CFP; FOV: 45 degrees.
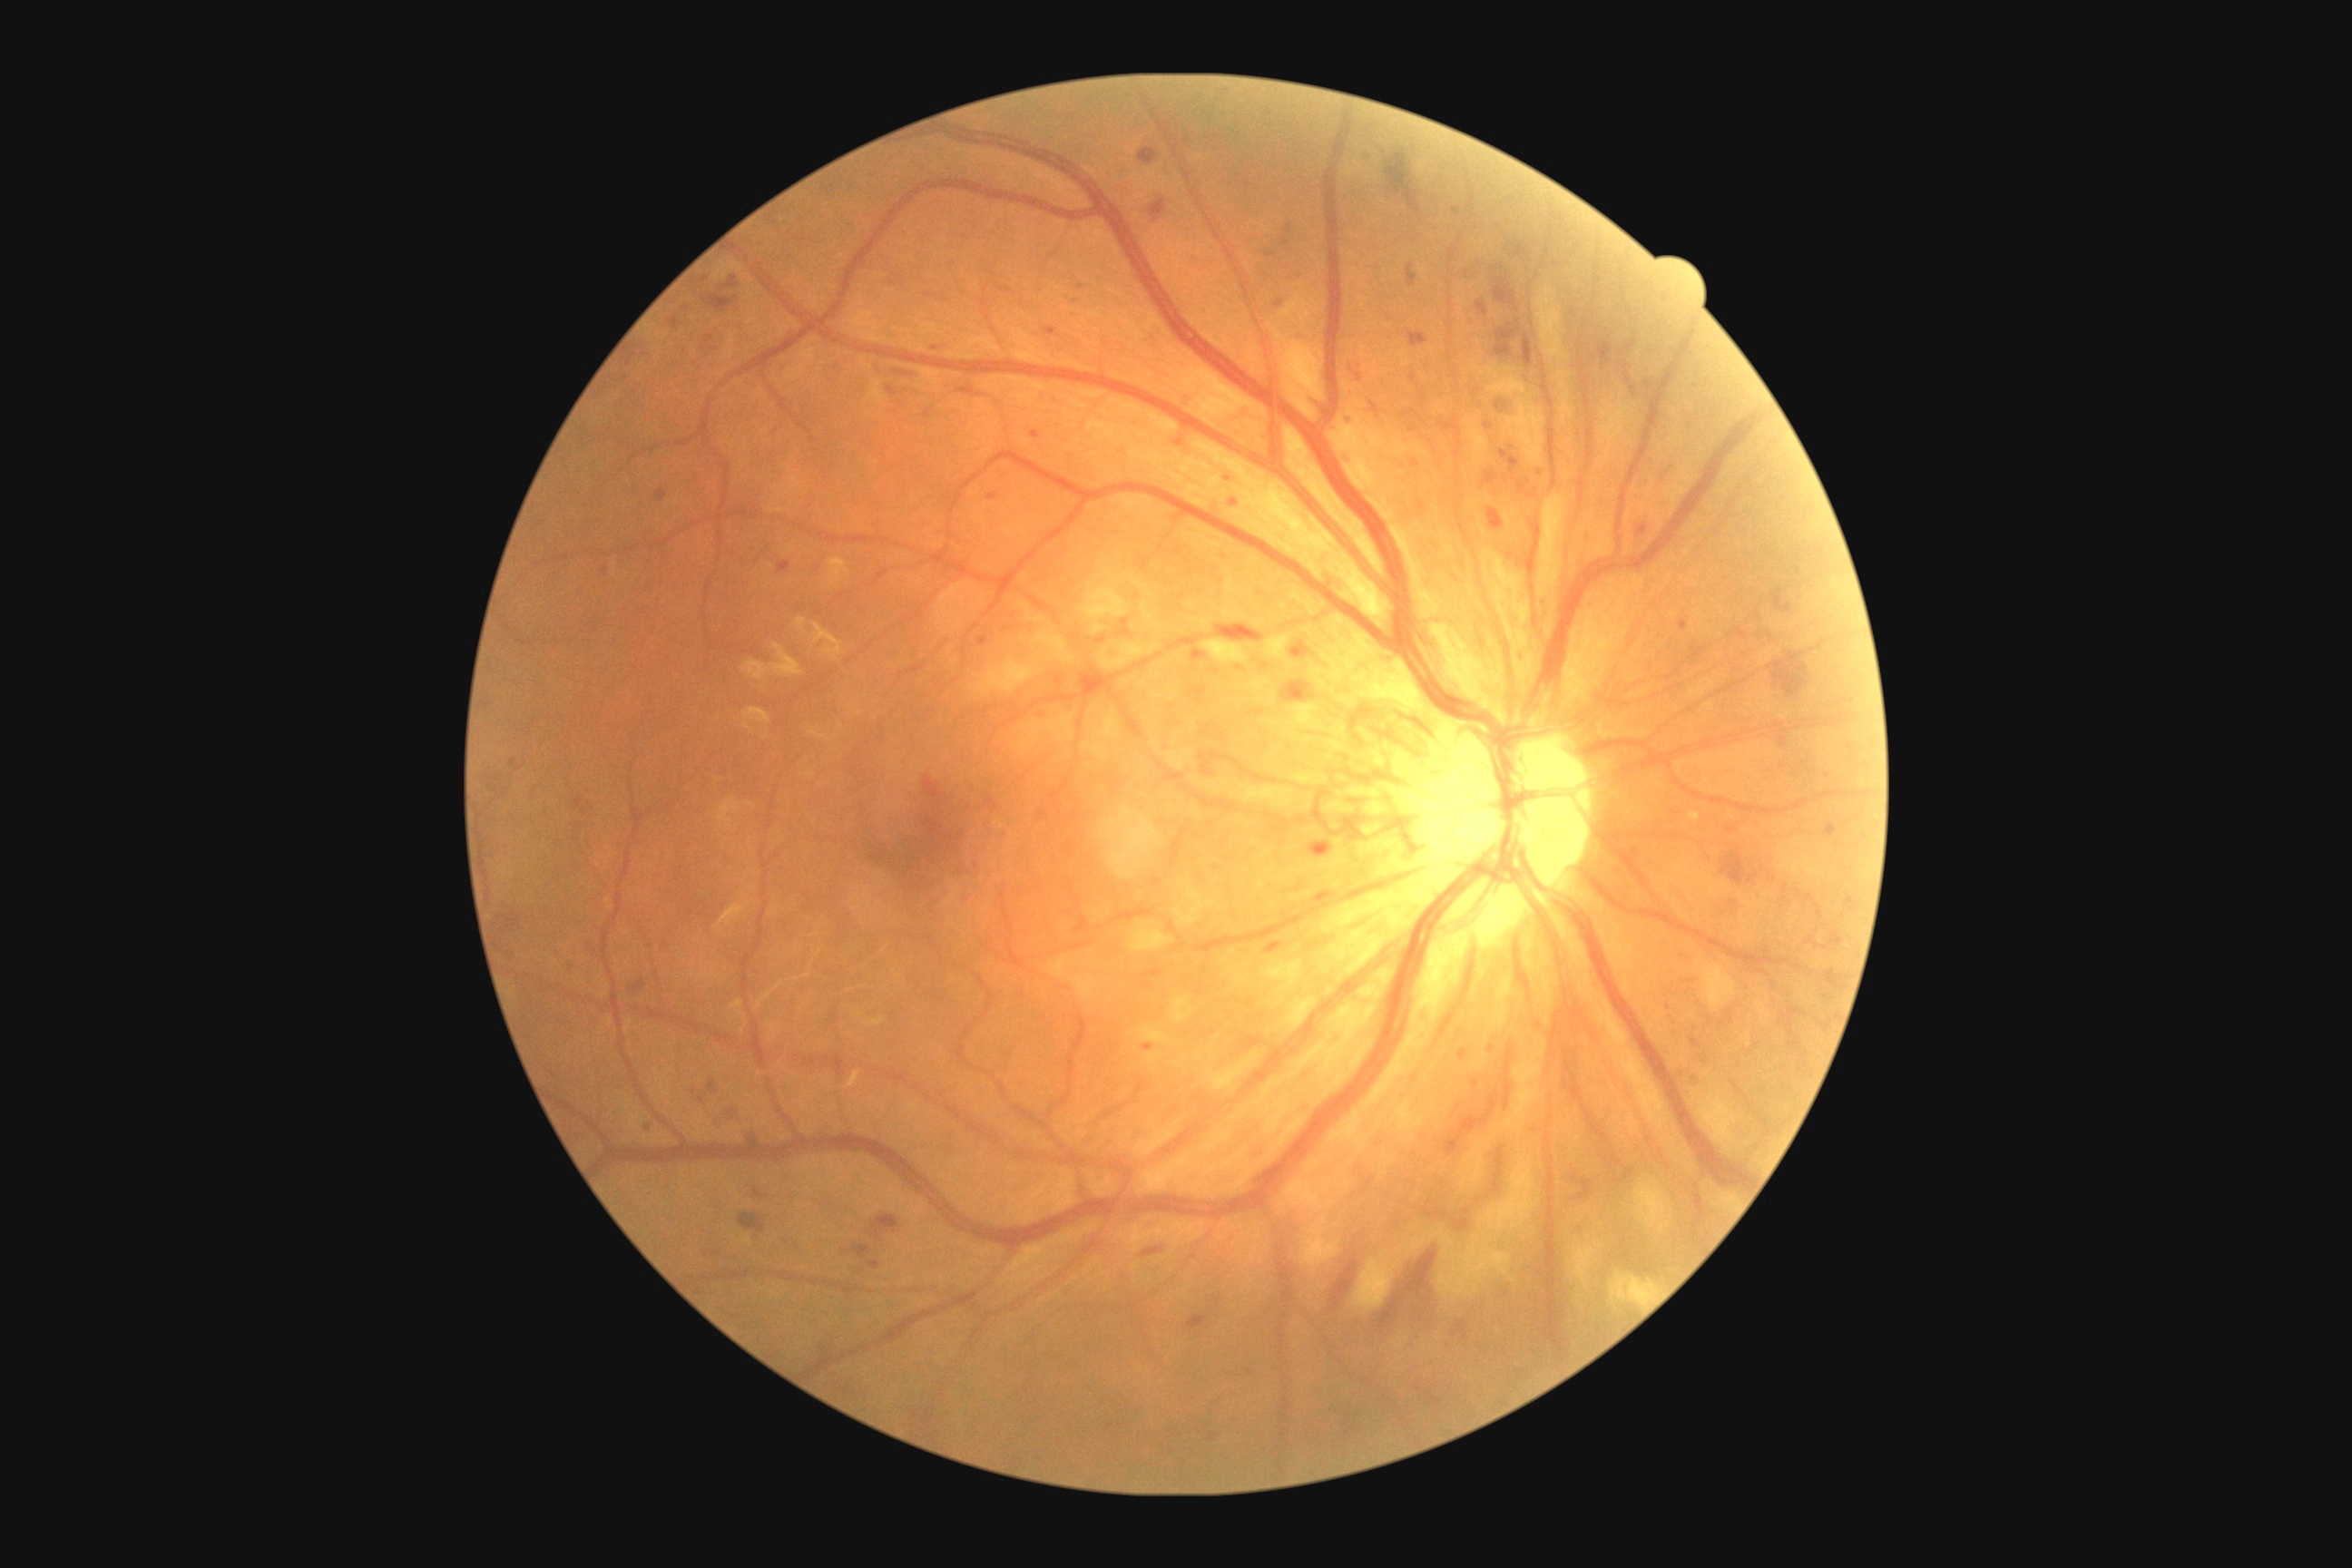 DR = 4.